240 by 240 pixels. CFP: 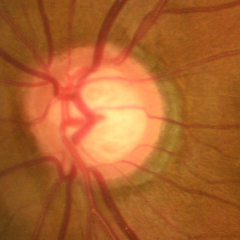 Assessment: early glaucoma.